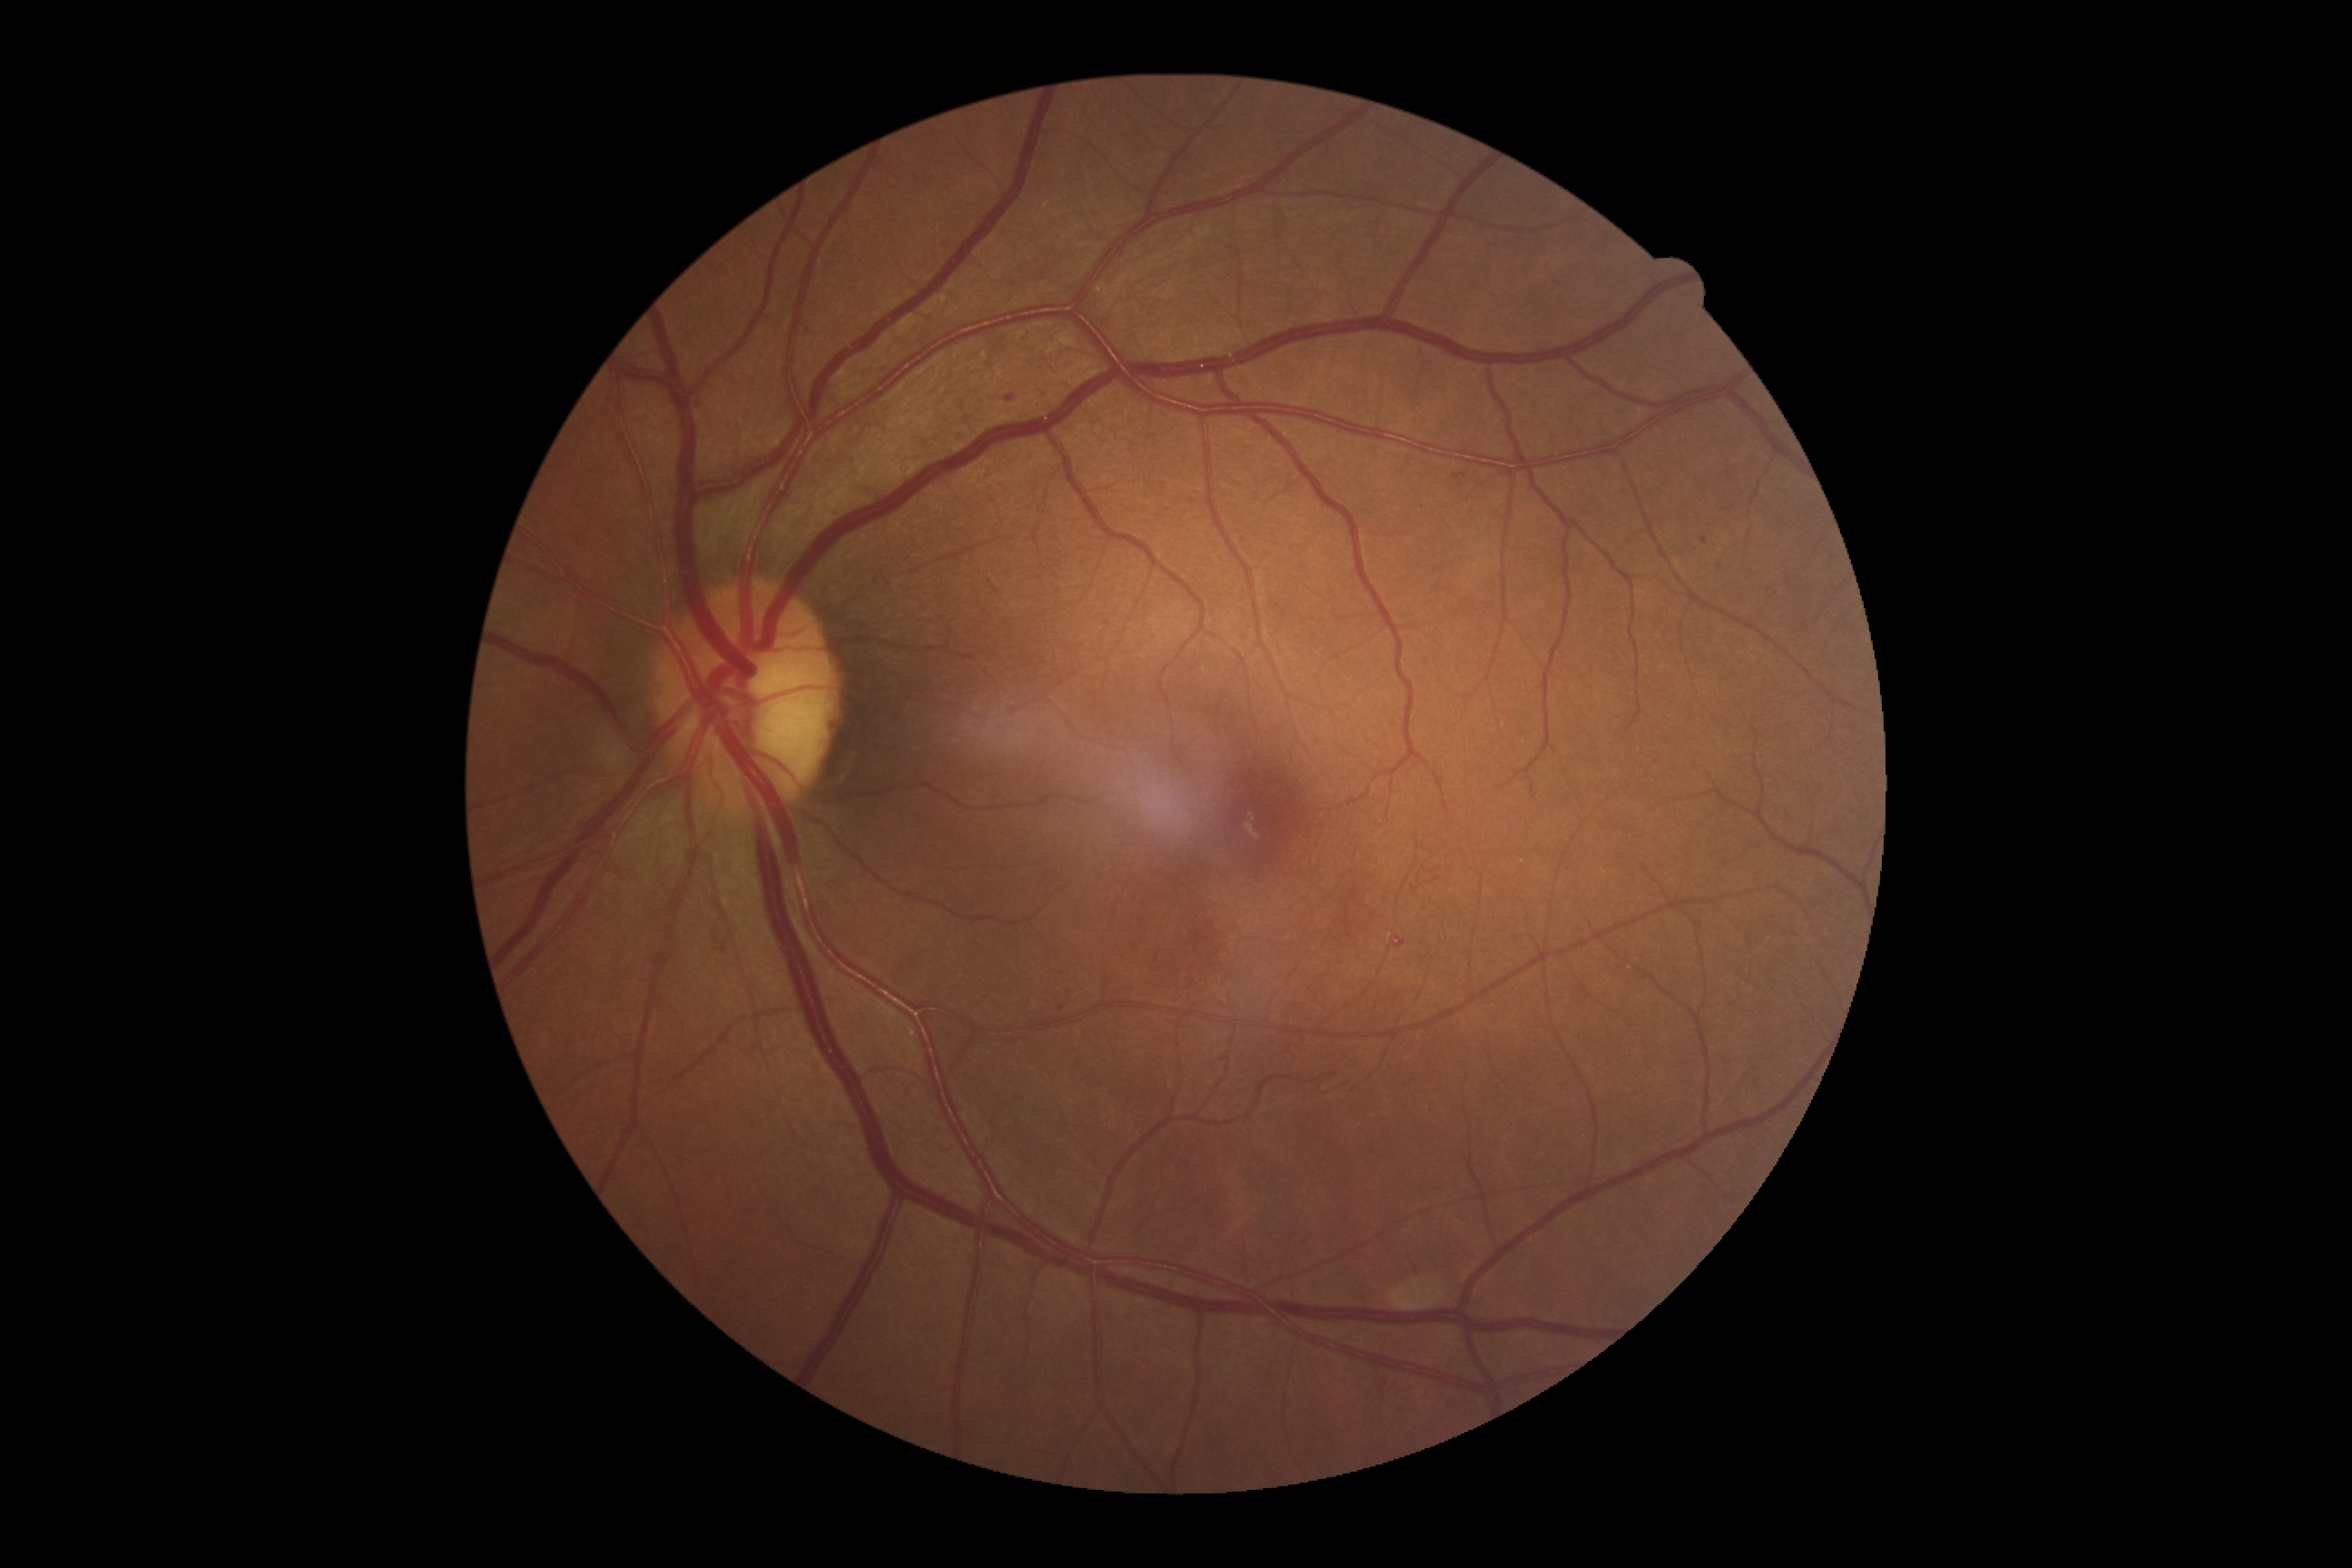

diabetic retinopathy: 3